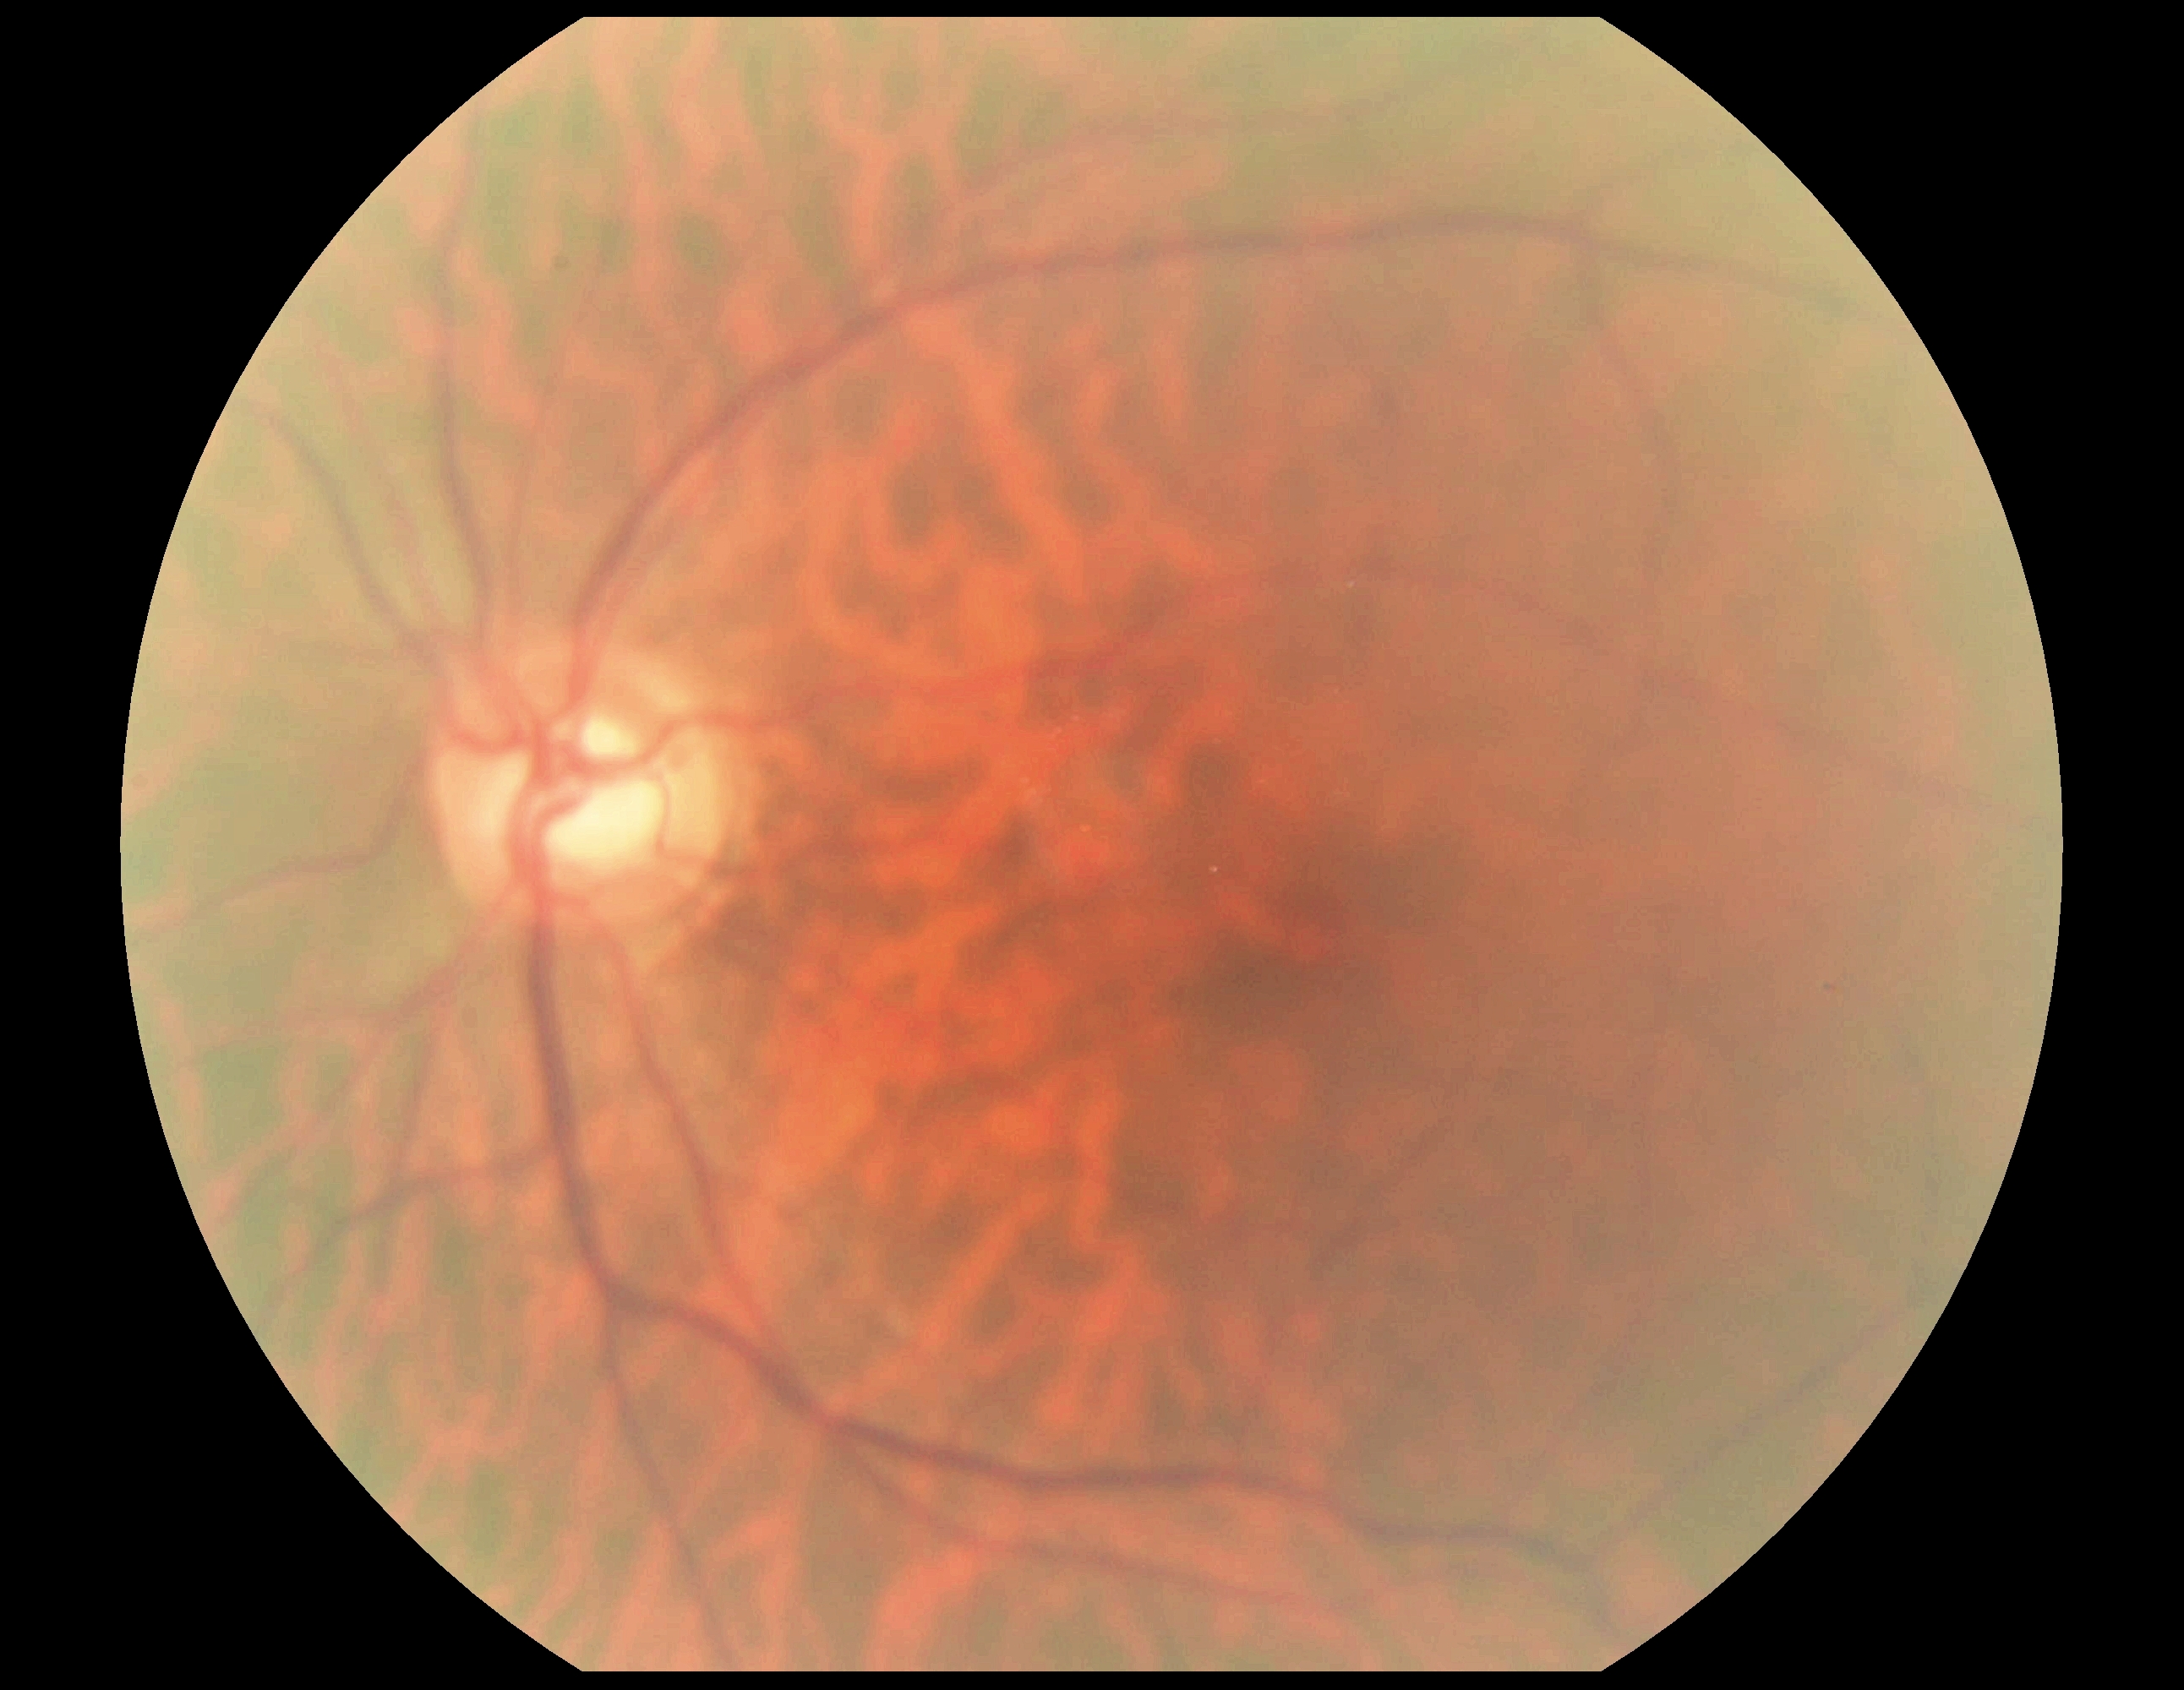

DR: 0, DR impression: no apparent DR.